100° field of view (Phoenix ICON); Phoenix ICON wide-field infant fundus image; 1240 x 1240 pixels:
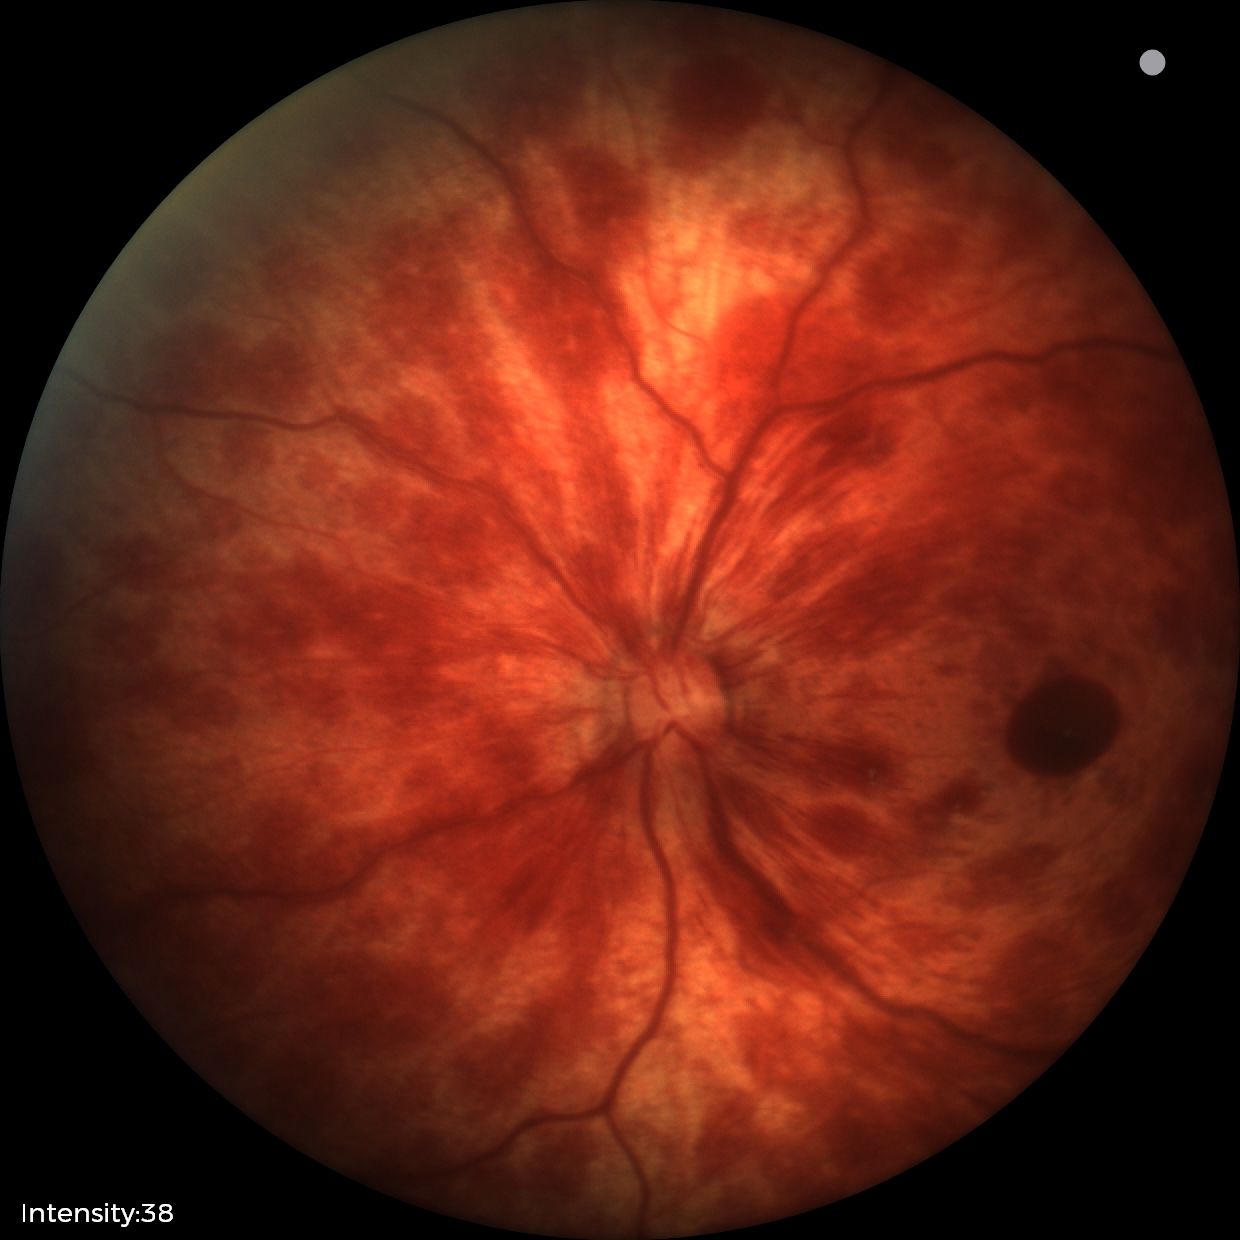 Screening series with retinal hemorrhages.